Modified Davis classification; posterior pole photograph: 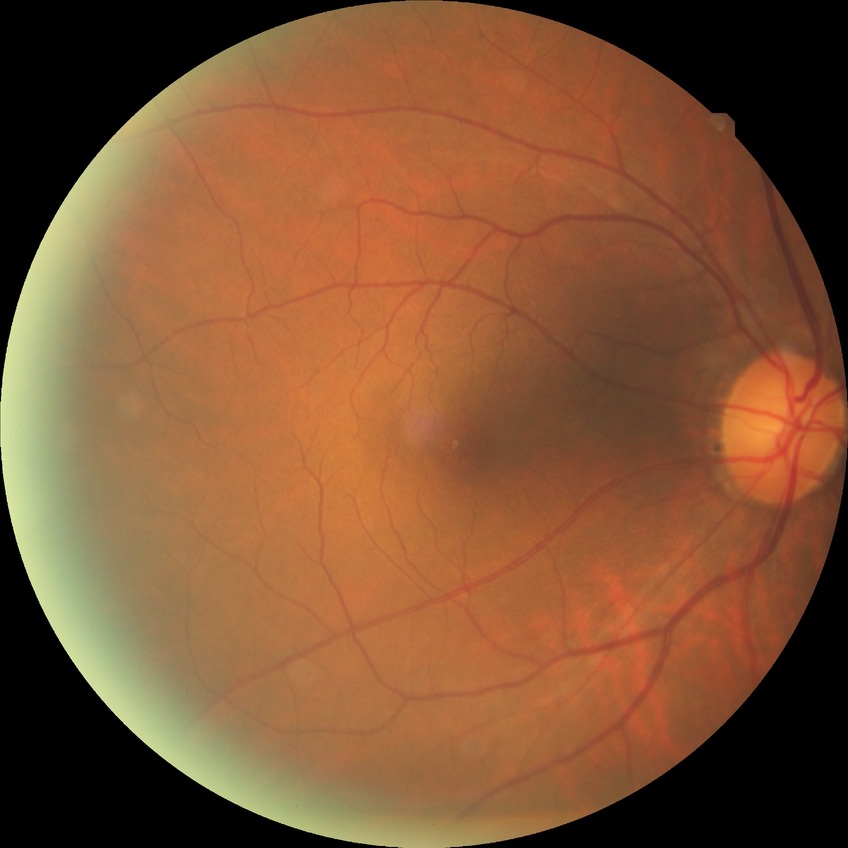 Diabetic retinopathy (DR): NDR (no diabetic retinopathy).